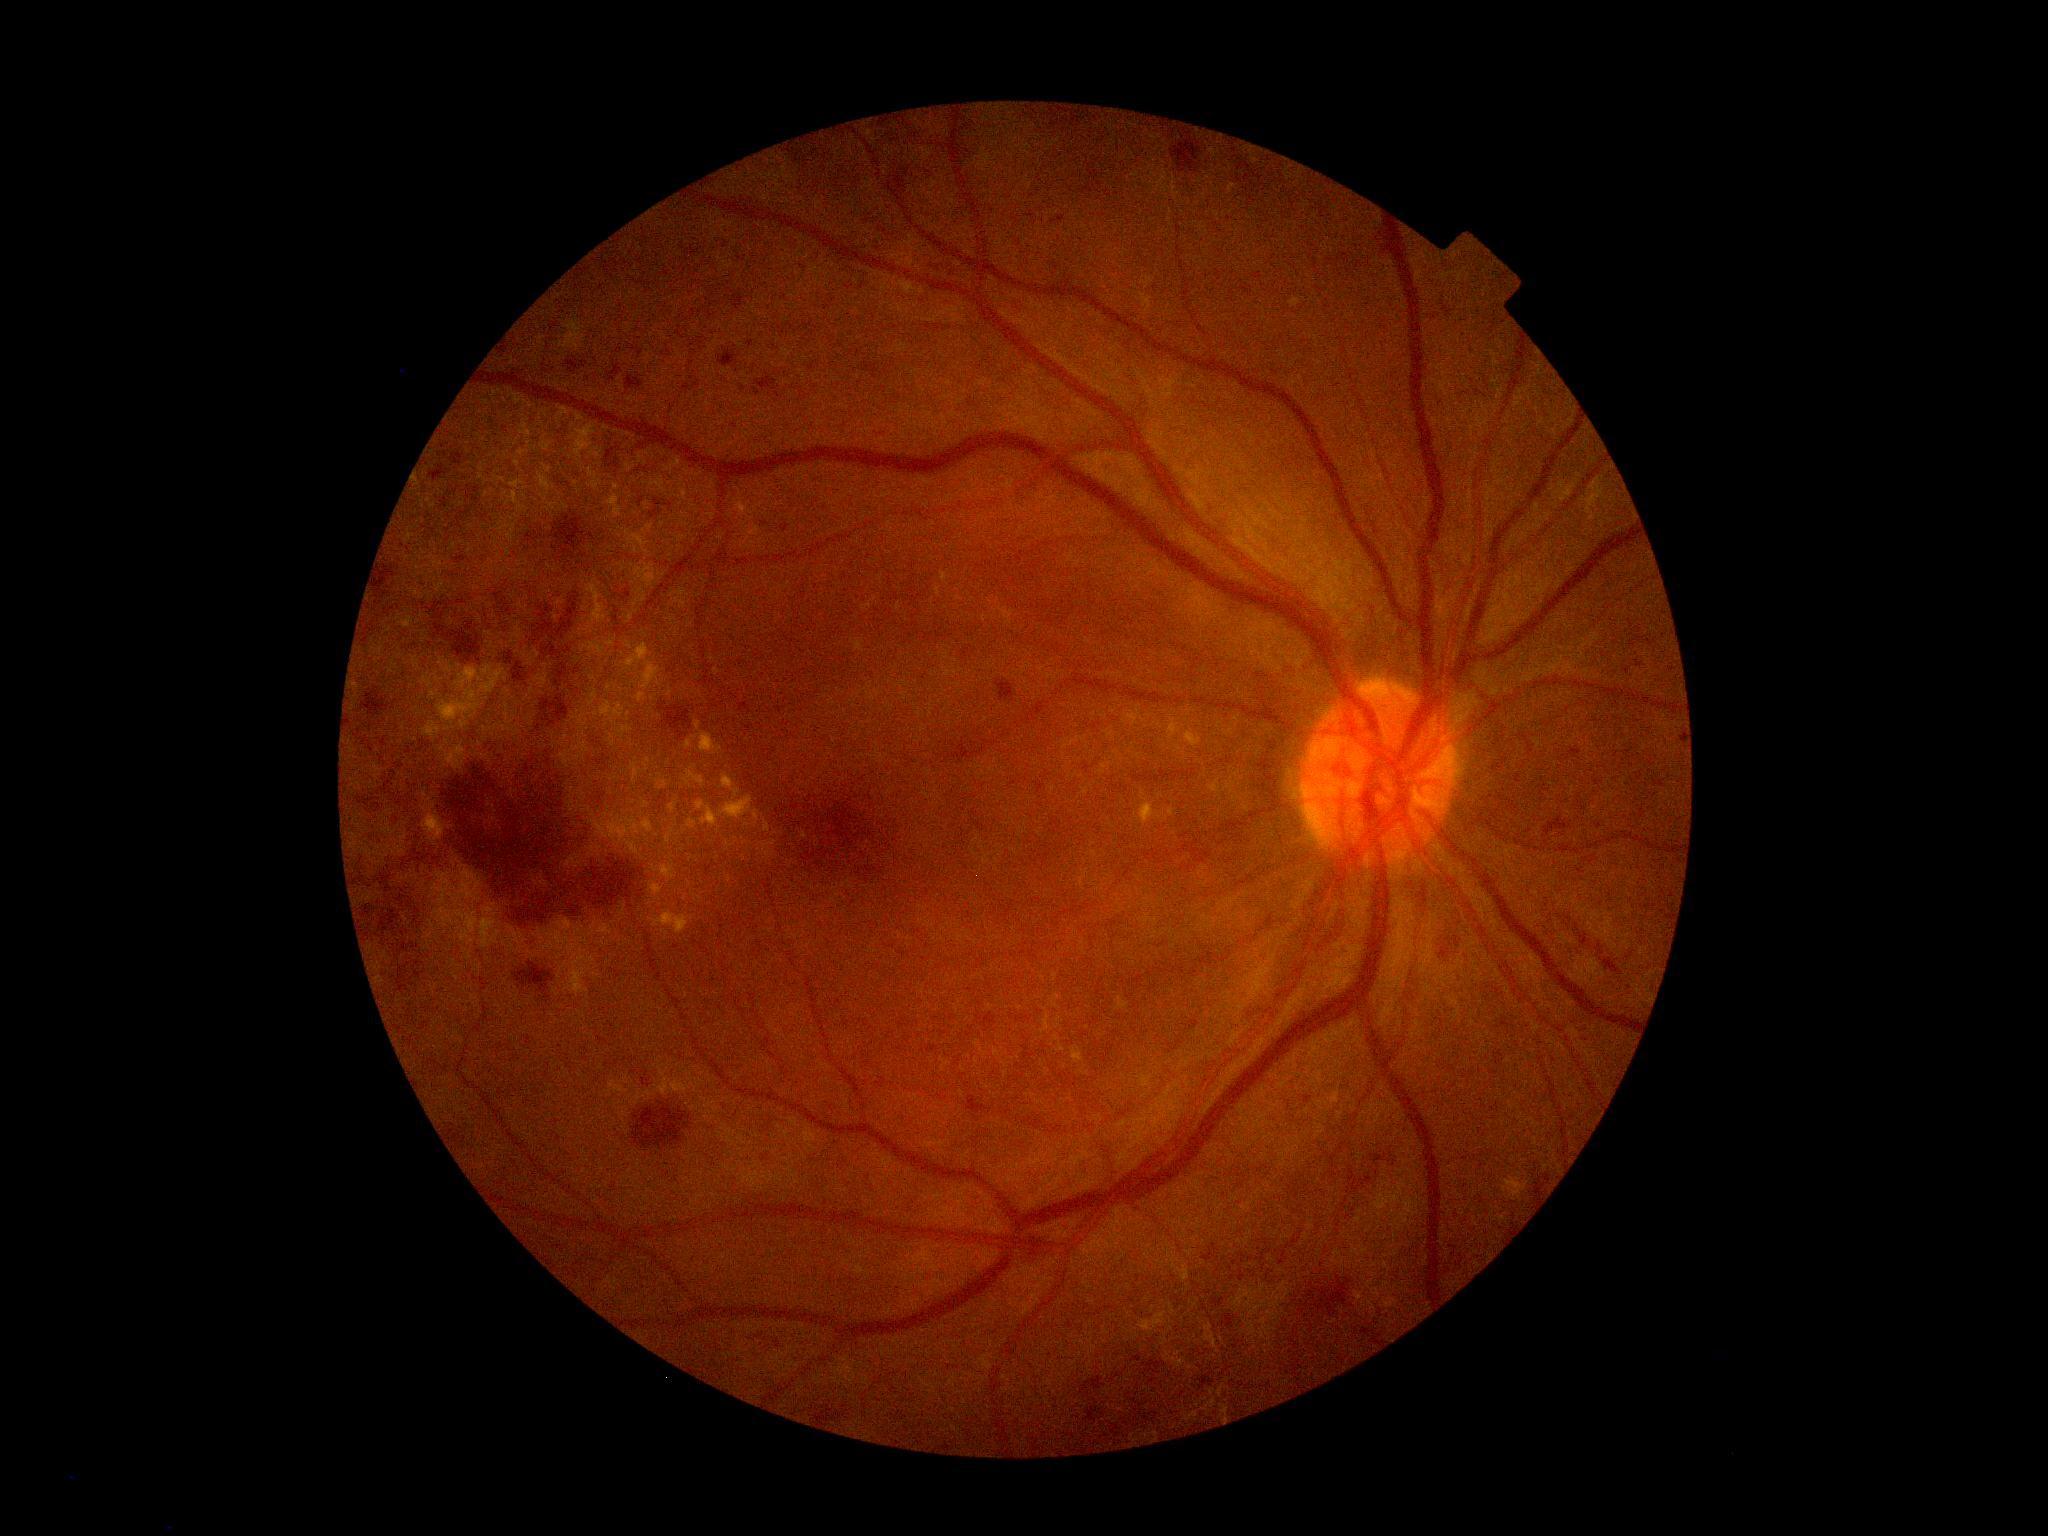 DR class: non-proliferative diabetic retinopathy.
Diabetic retinopathy (DR) is grade 3.